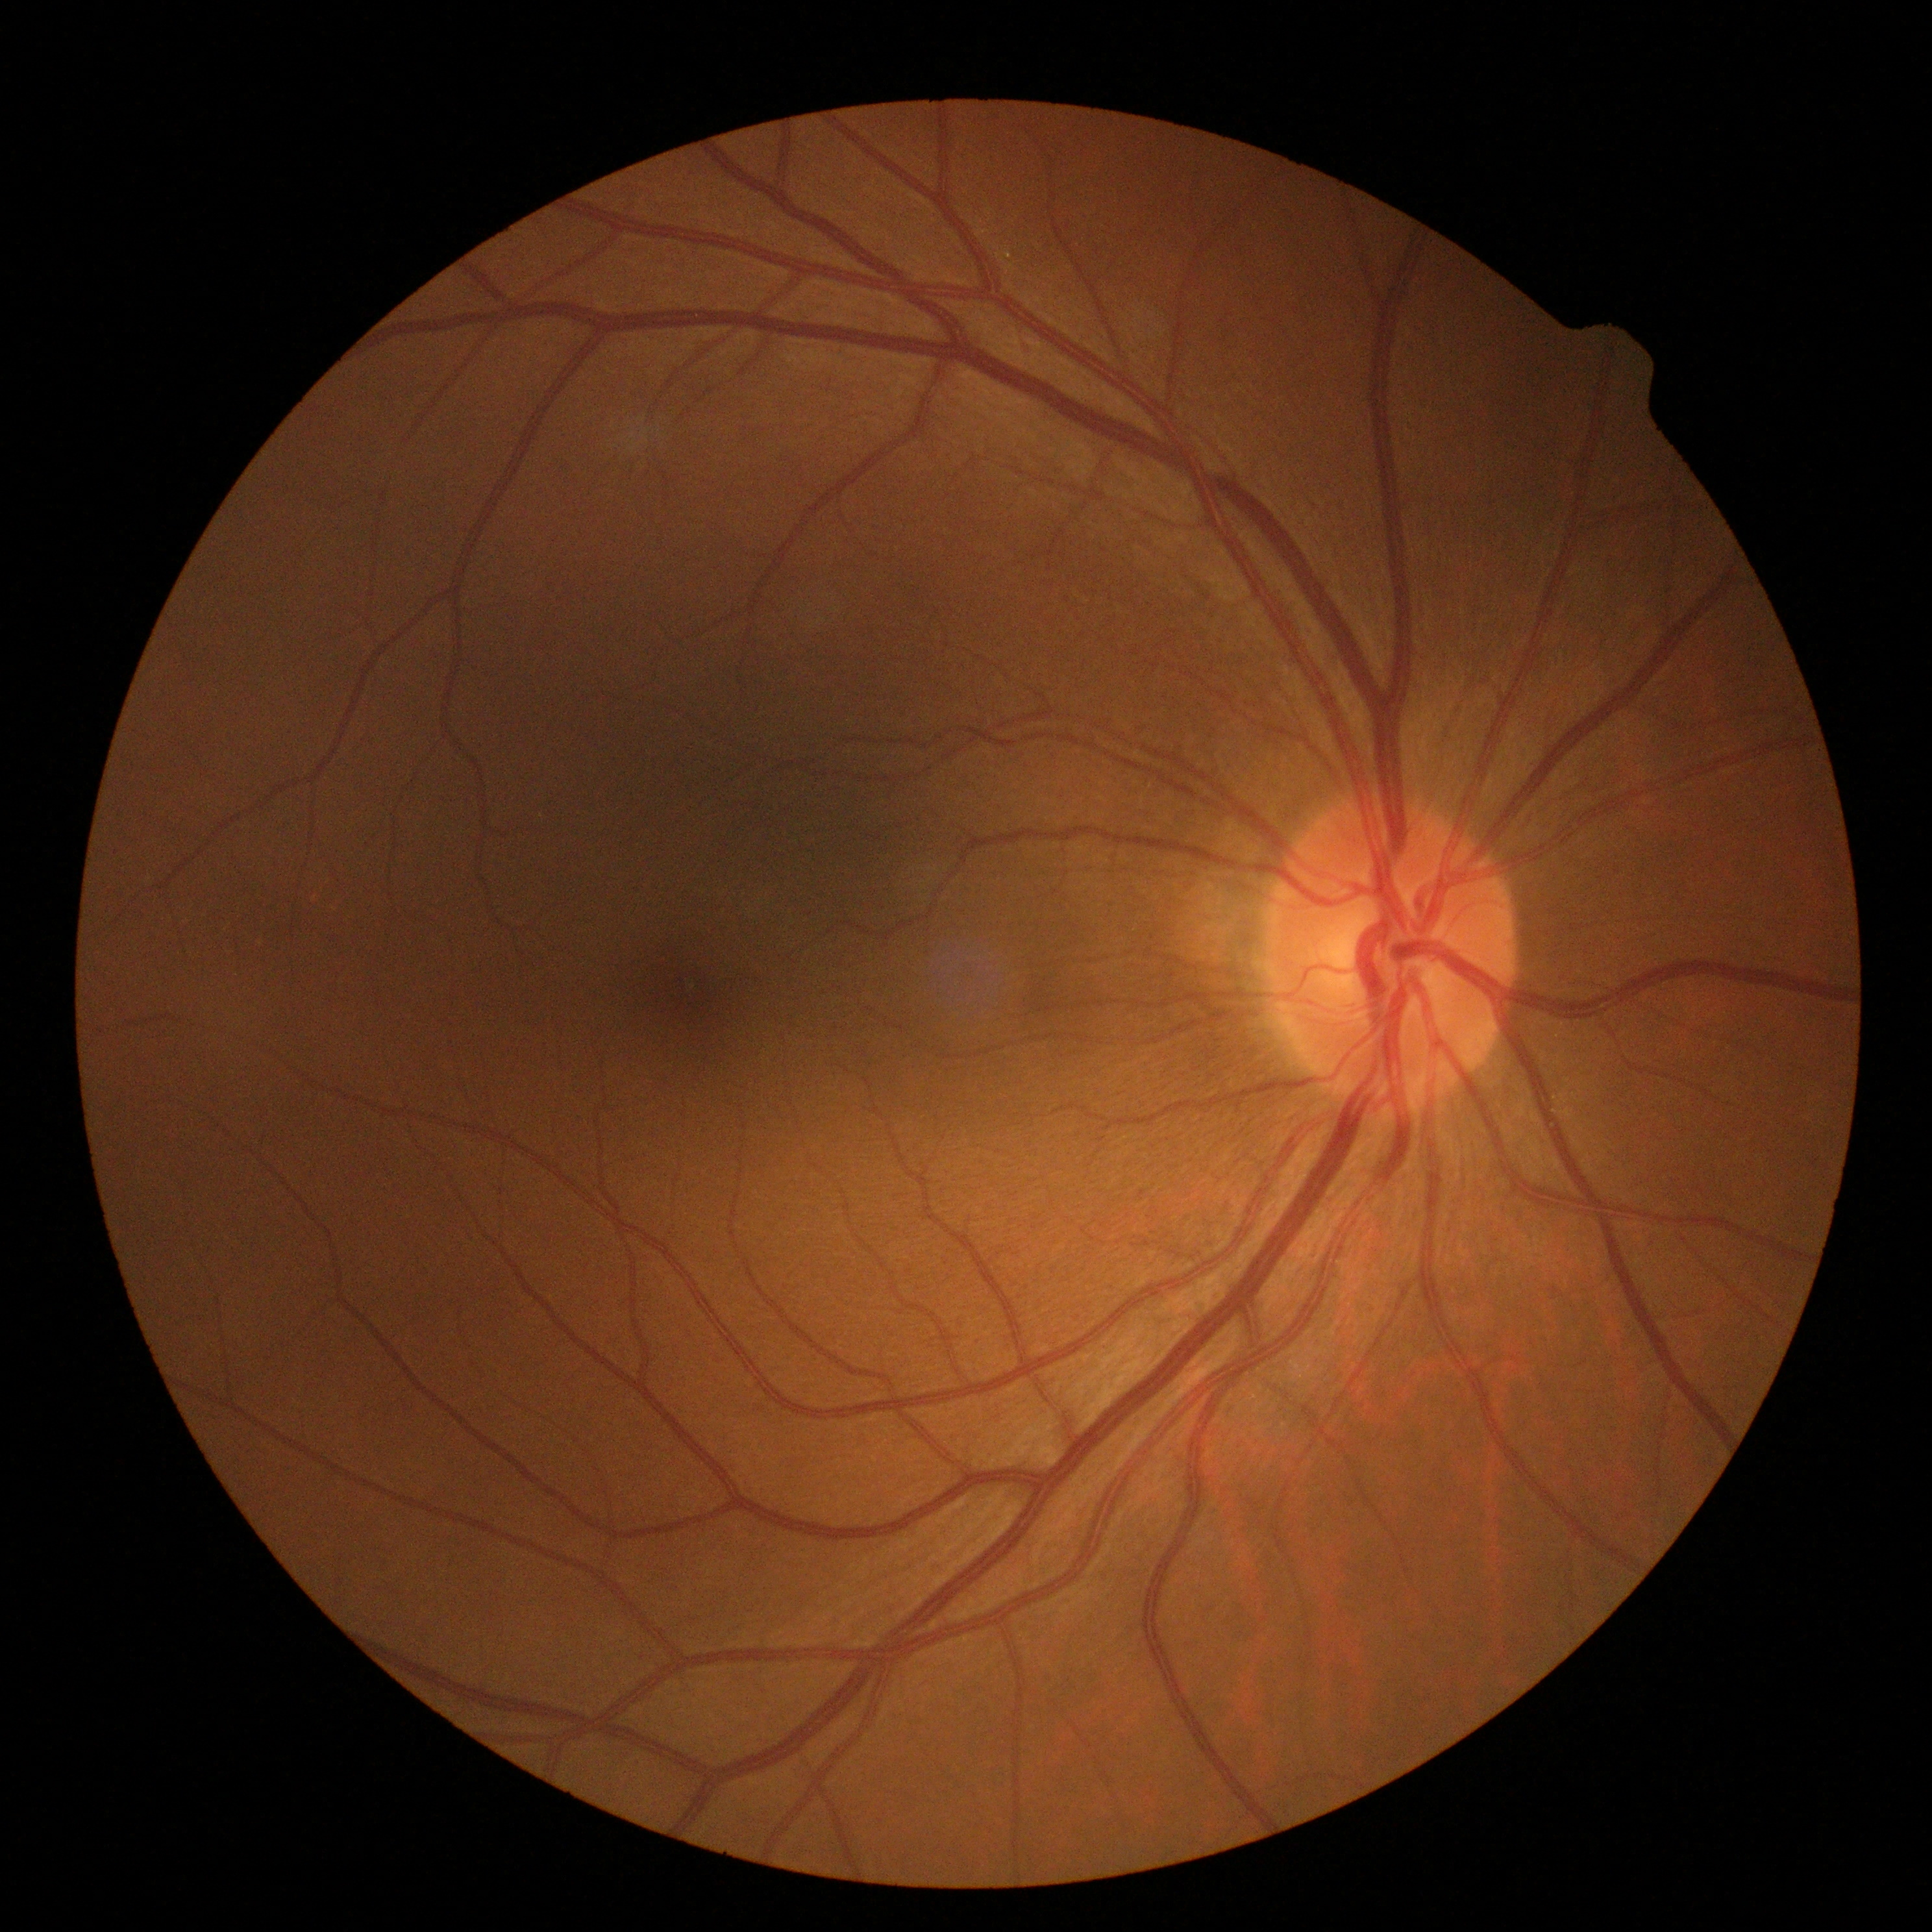

diabetic retinopathy (DR)@0.